Infant wide-field fundus photograph
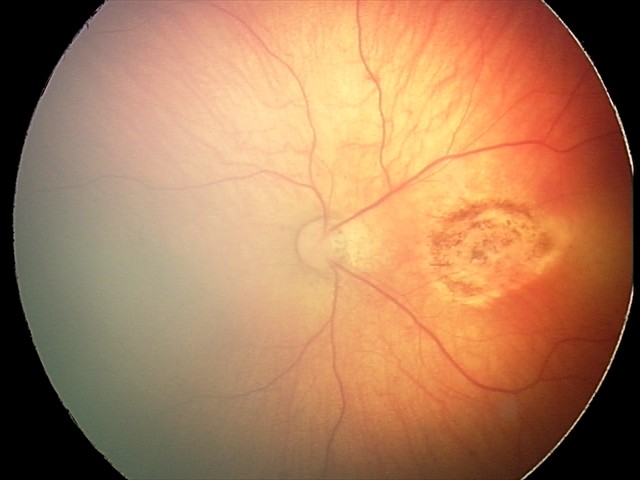

Q: What was the screening finding?
A: toxoplasmosis chorioretinitis